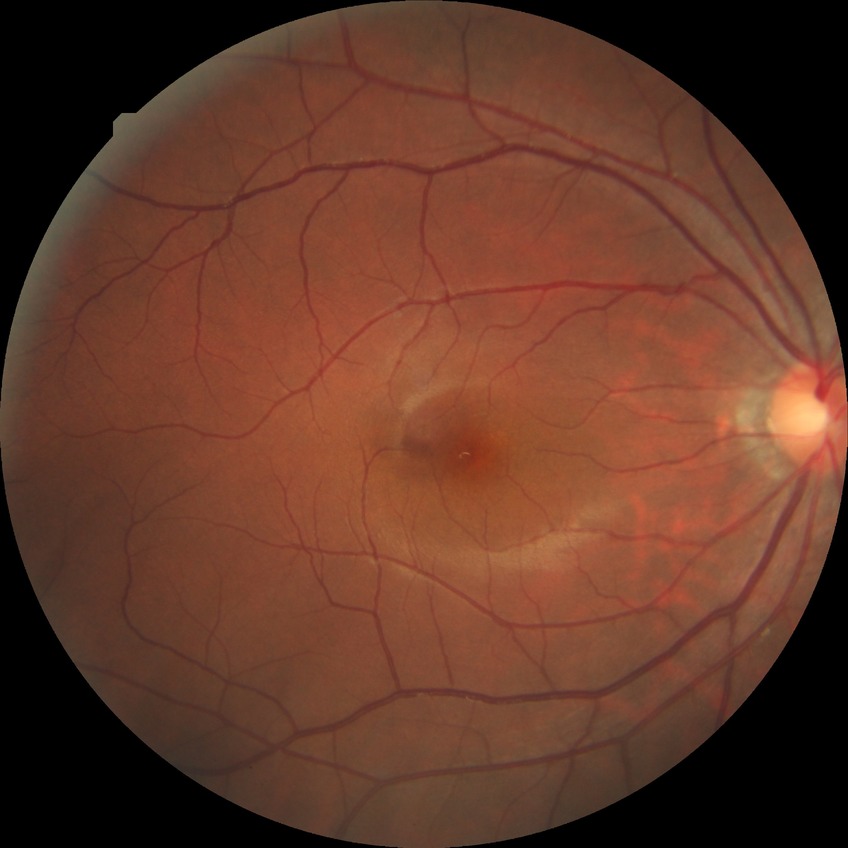

Diabetic retinopathy (DR): NDR (no diabetic retinopathy).